RetCam wide-field infant fundus image — 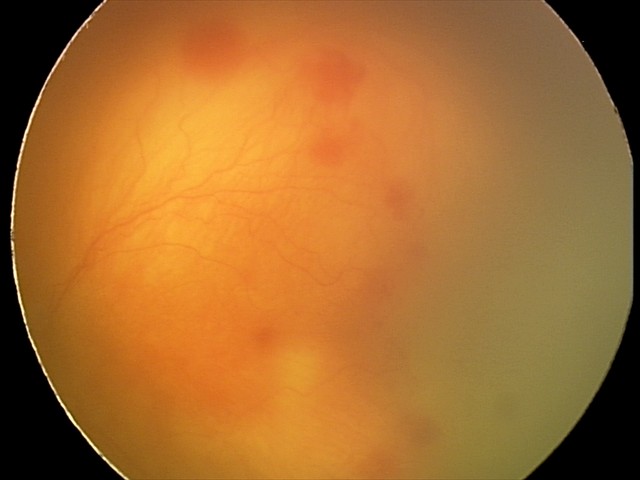

Screening examination consistent with aggressive retinopathy of prematurity (A-ROP) — rapidly progressive severe ROP with prominent plus disease, often without classic stage progression.
Plus disease was diagnosed.